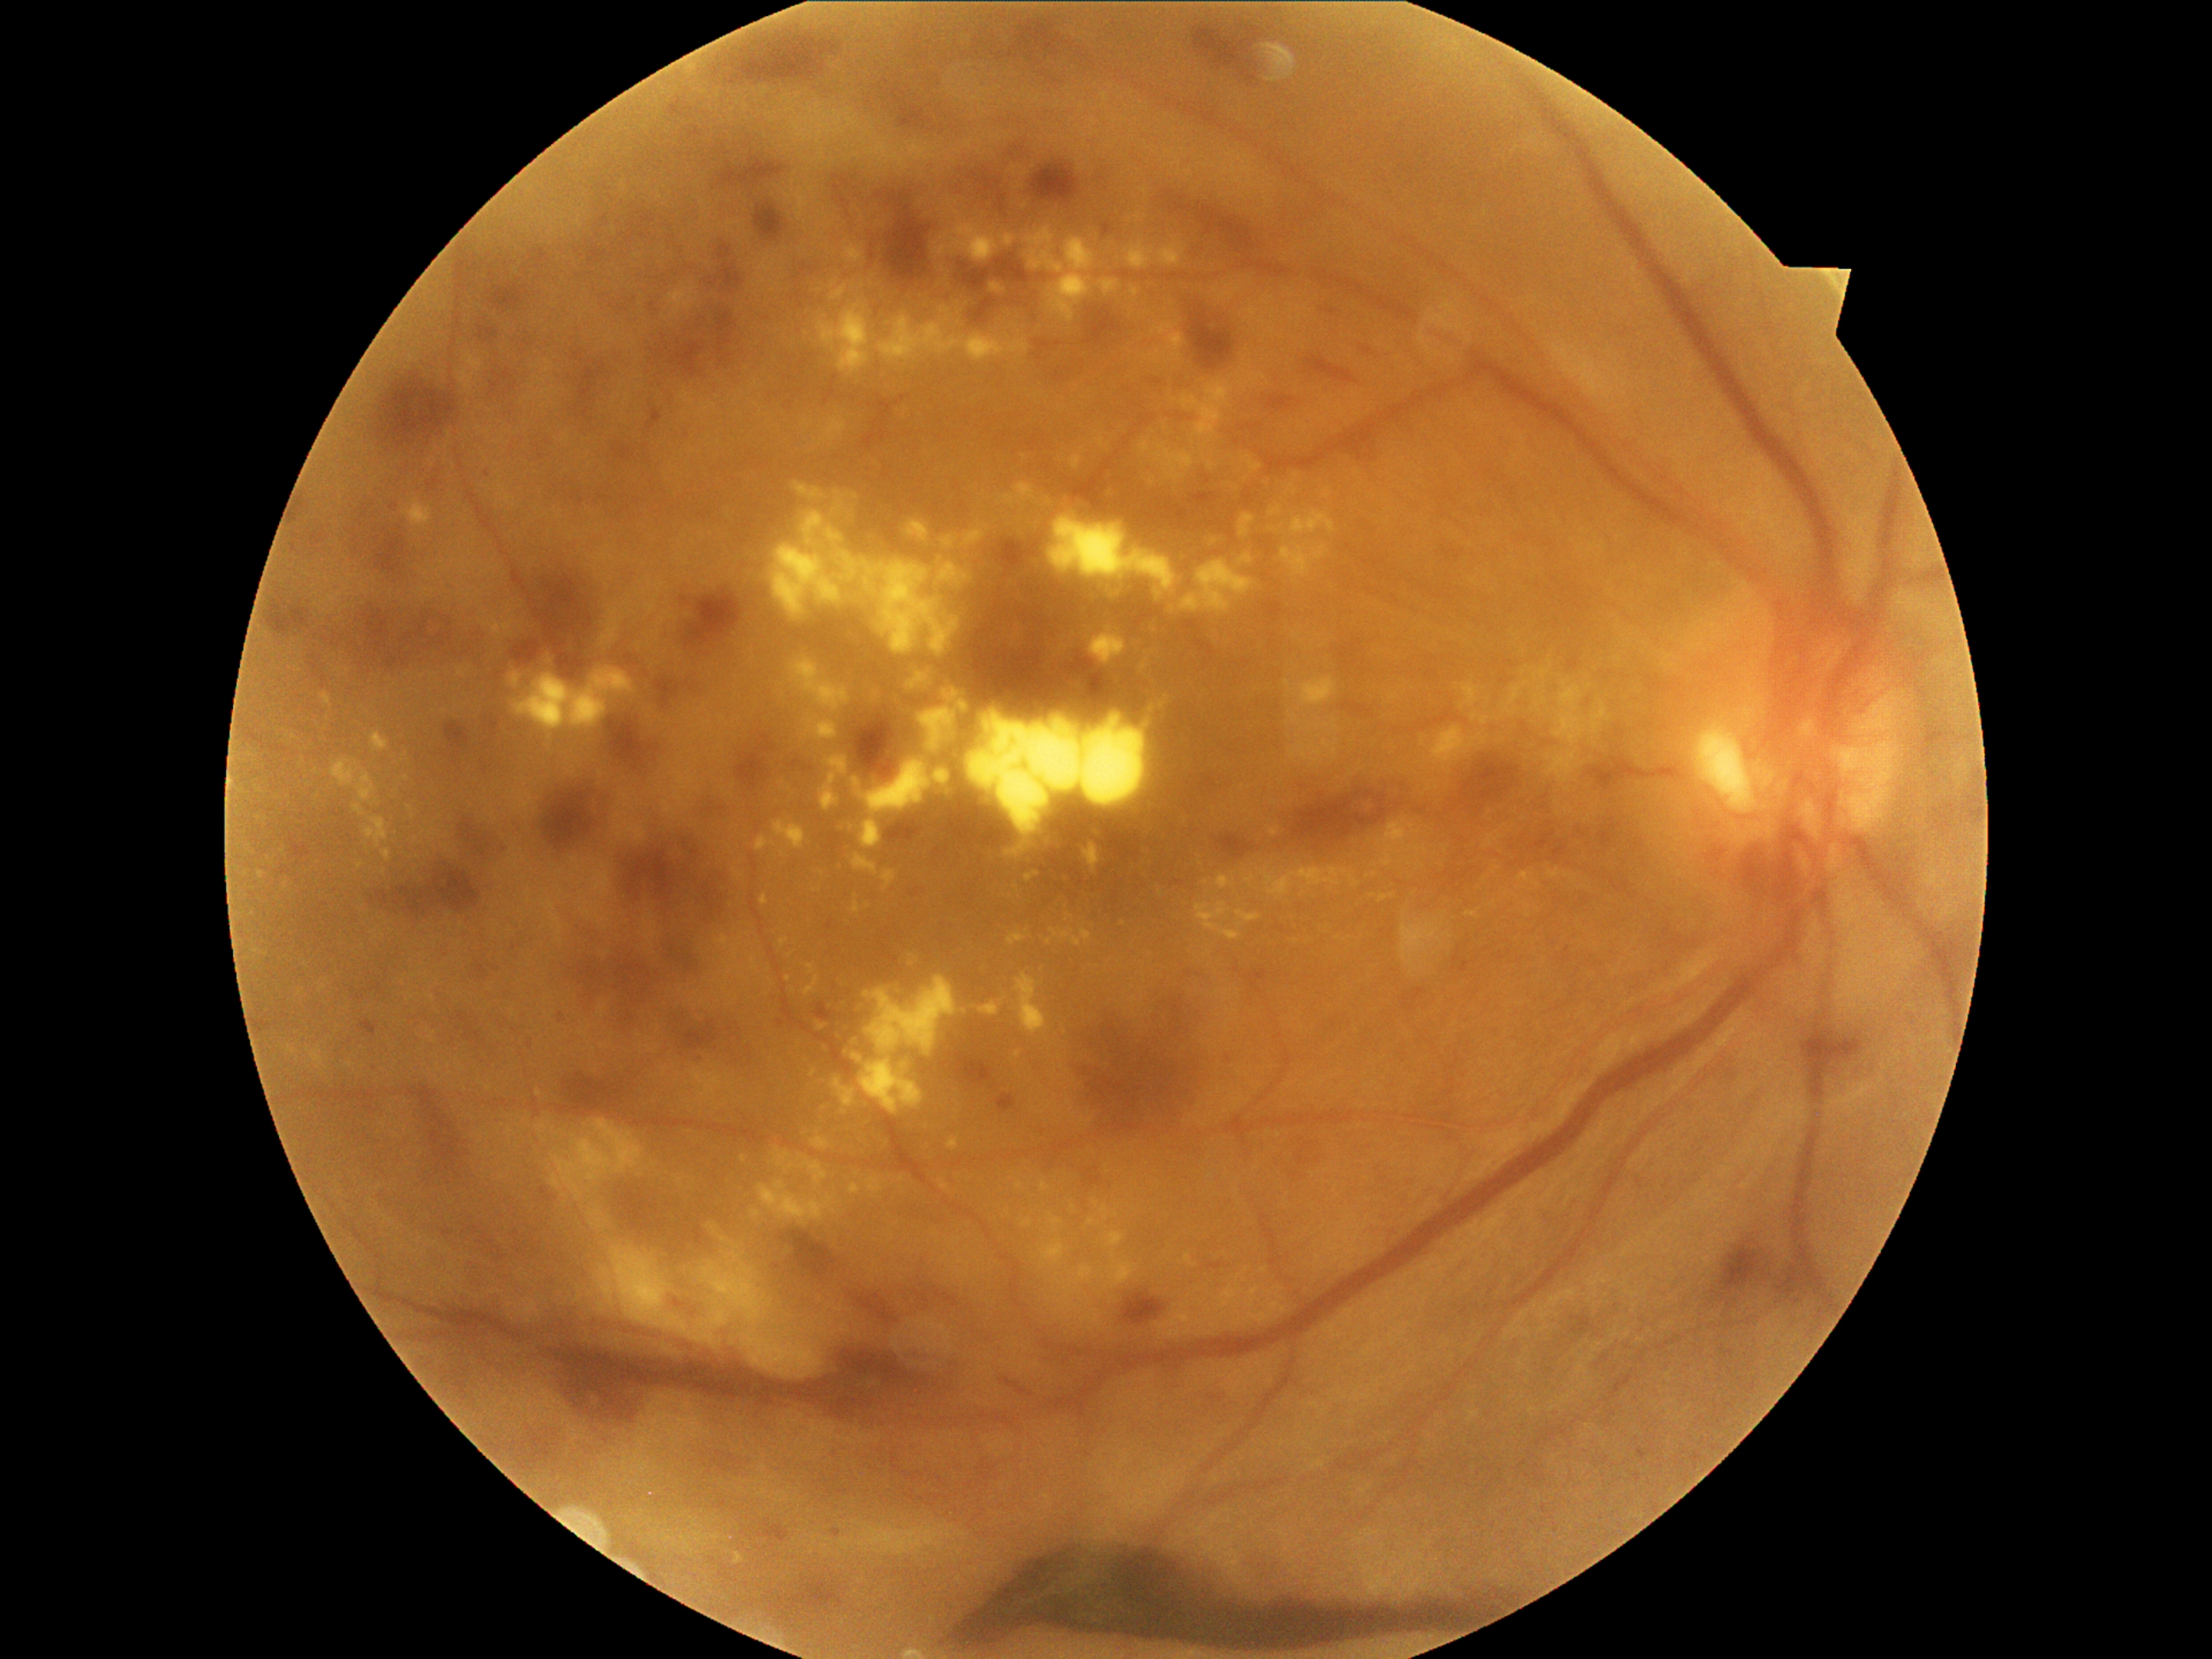
Diabetic retinopathy (DR) is grade 4 (PDR). Hard exudates (EXs) are present, including at 1547/748/1578/784 | 311/1049/325/1068 | 405/501/433/527 | 1180/559/1255/614 | 322/692/332/706 | 371/731/390/754 | 1040/1182/1051/1192 | 1324/402/1332/409 | 950/224/999/264 | 991/284/1006/296 | 1112/1254/1117/1262 | 1332/721/1341/731 | 805/975/820/996. Small EXs approximately at x=1074, y=1208 | x=1237, y=1279 | x=1574, y=879 | x=1161, y=893 | x=1436, y=955 | x=868, y=906 | x=414, y=977.